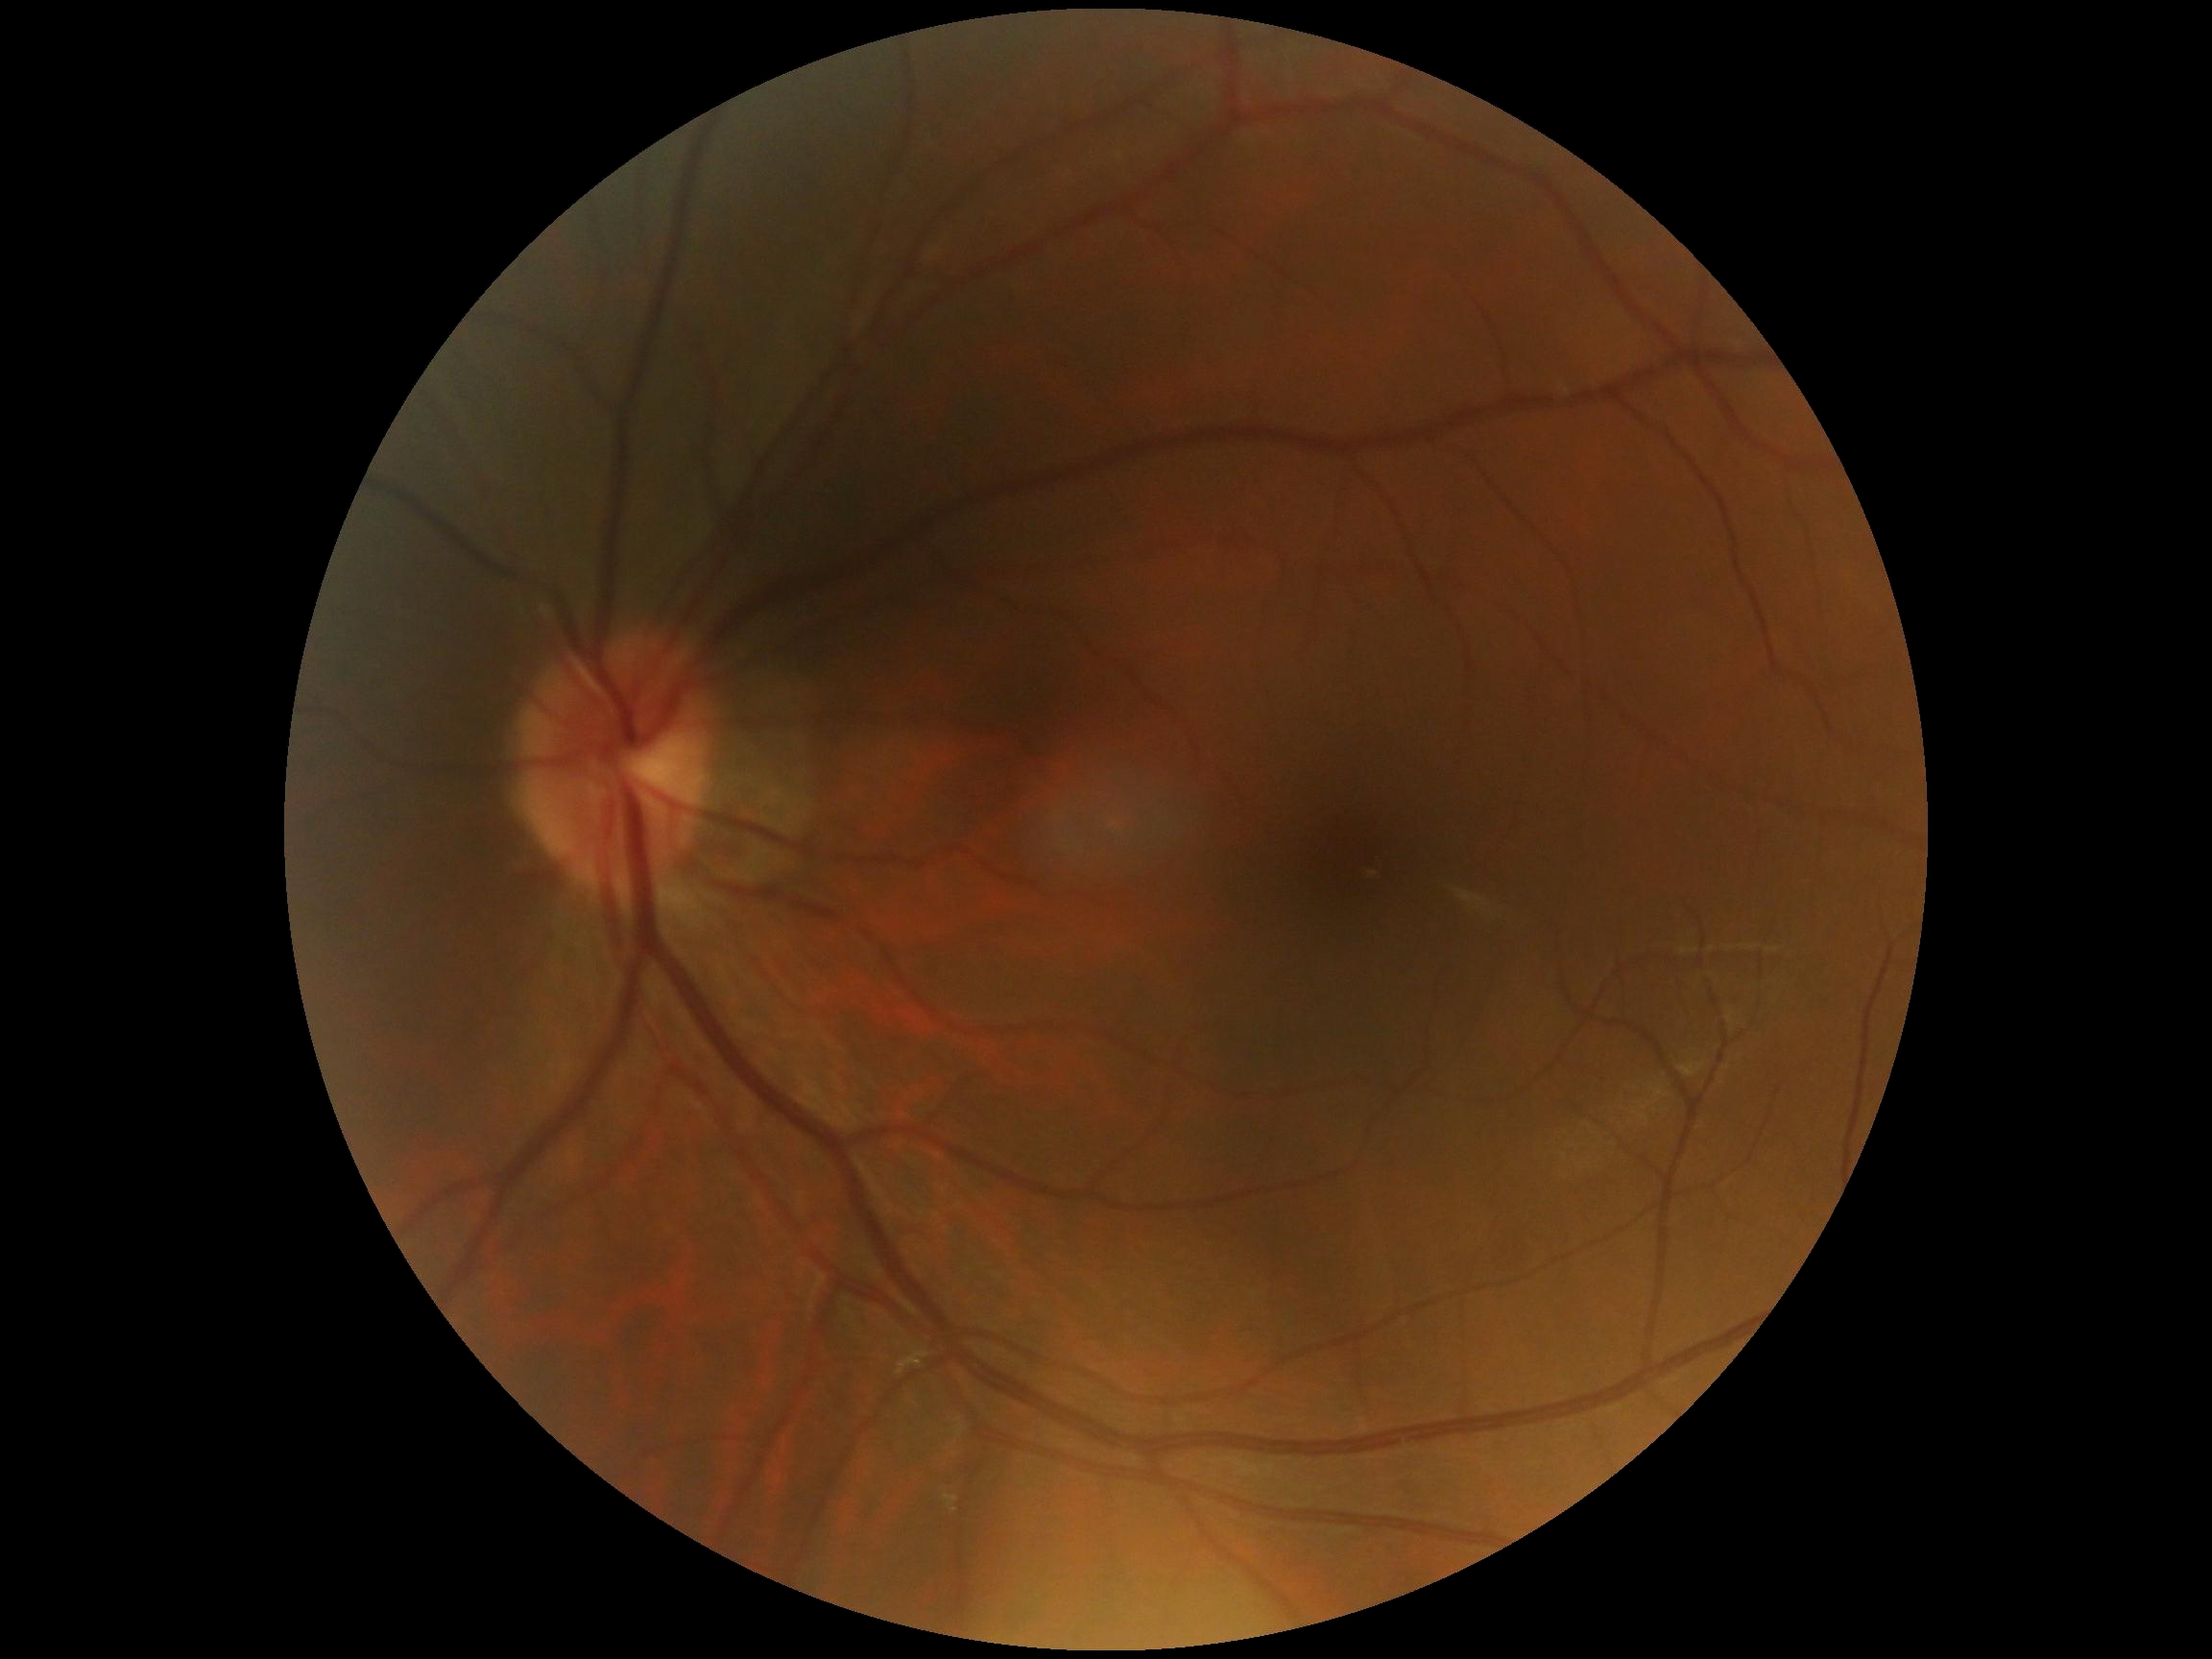
retinopathy: grade 0 (no apparent retinopathy).